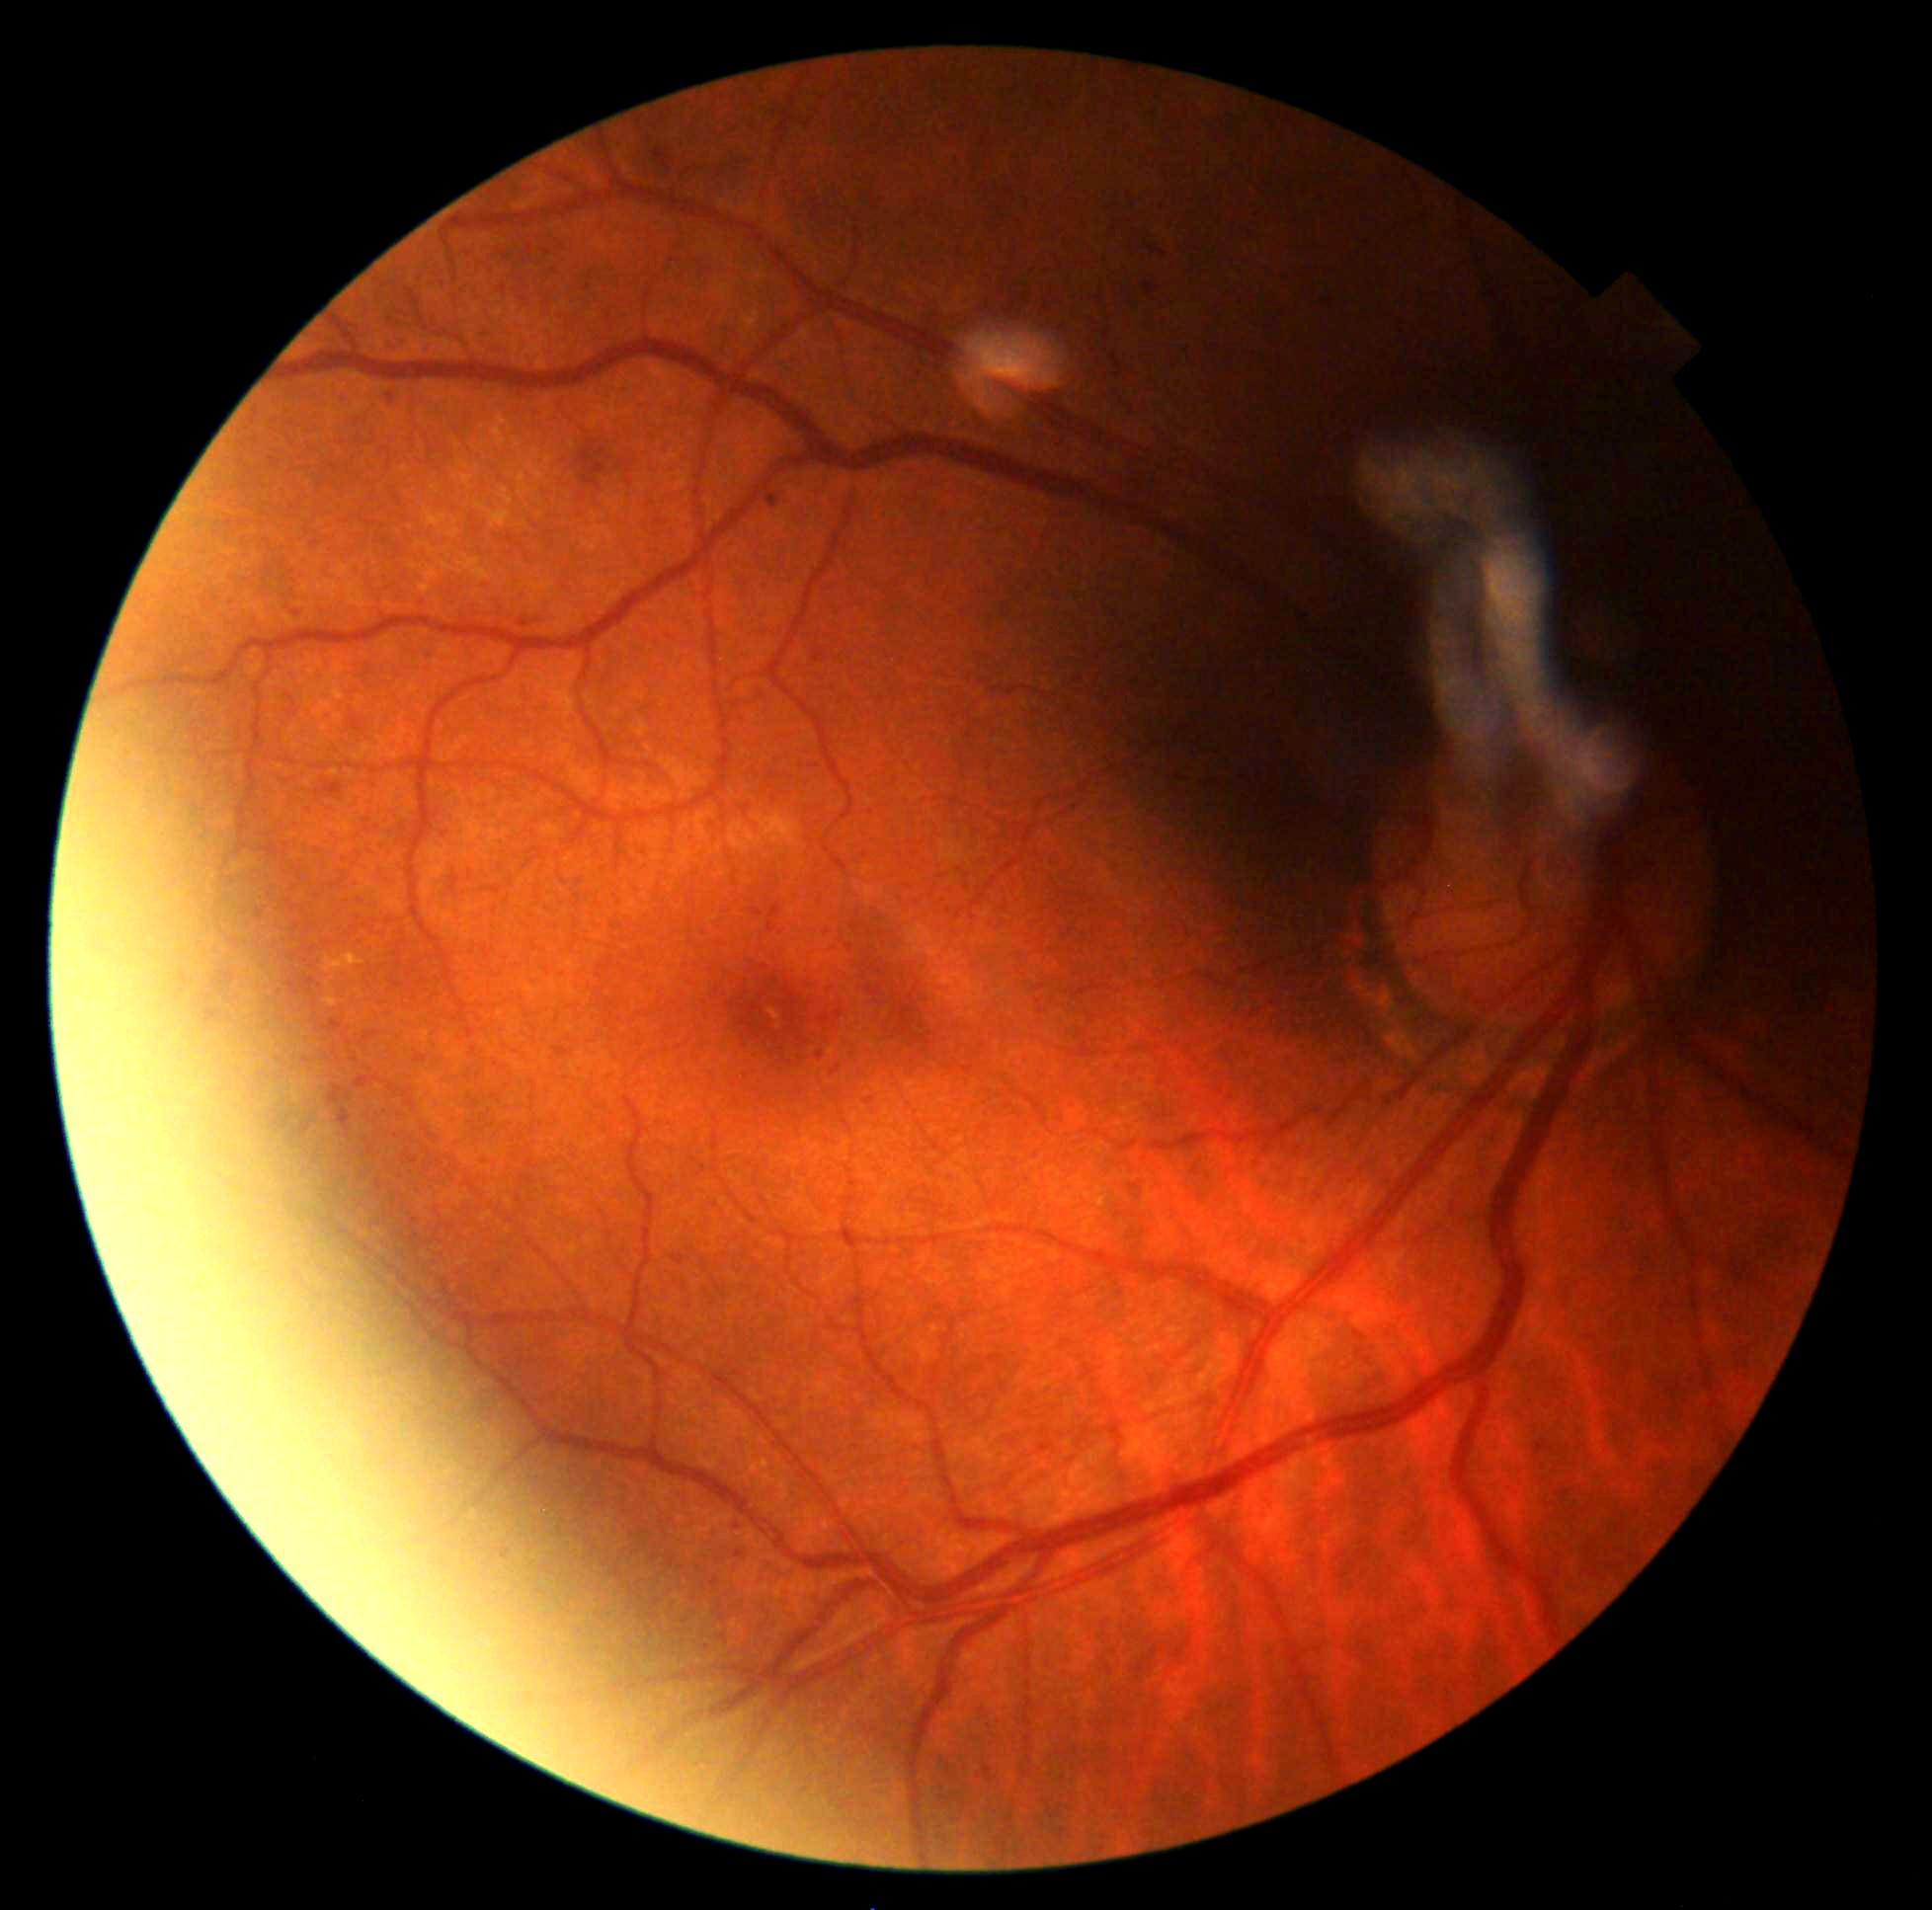
DR is grade 2.